Color fundus photograph; image size 848x848.
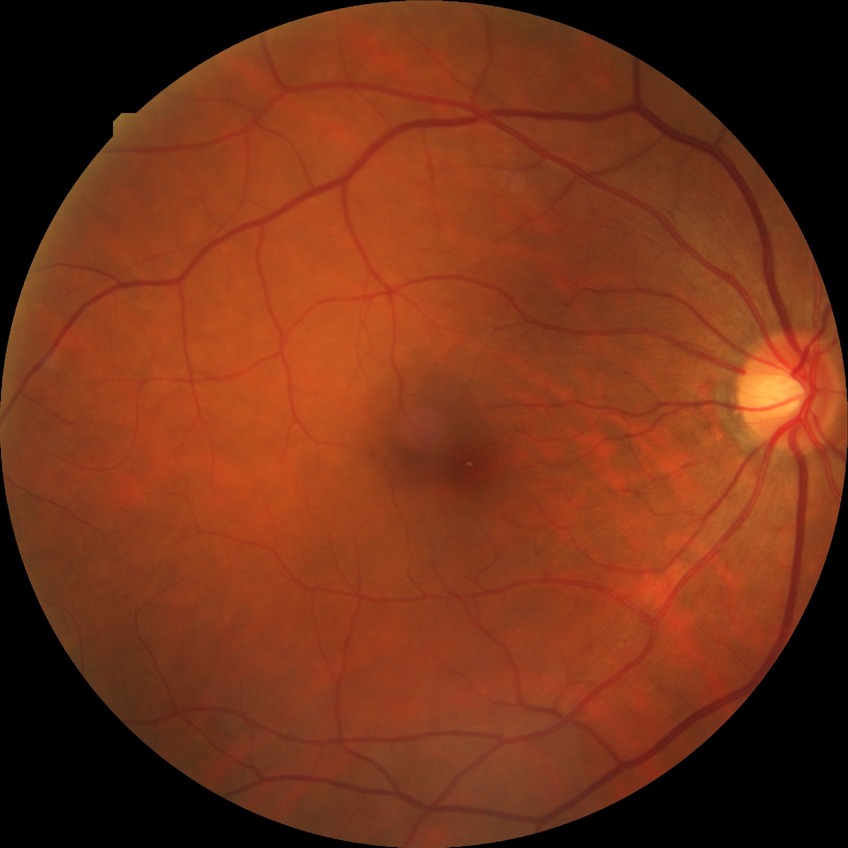

modified Davis grading: no diabetic retinopathy